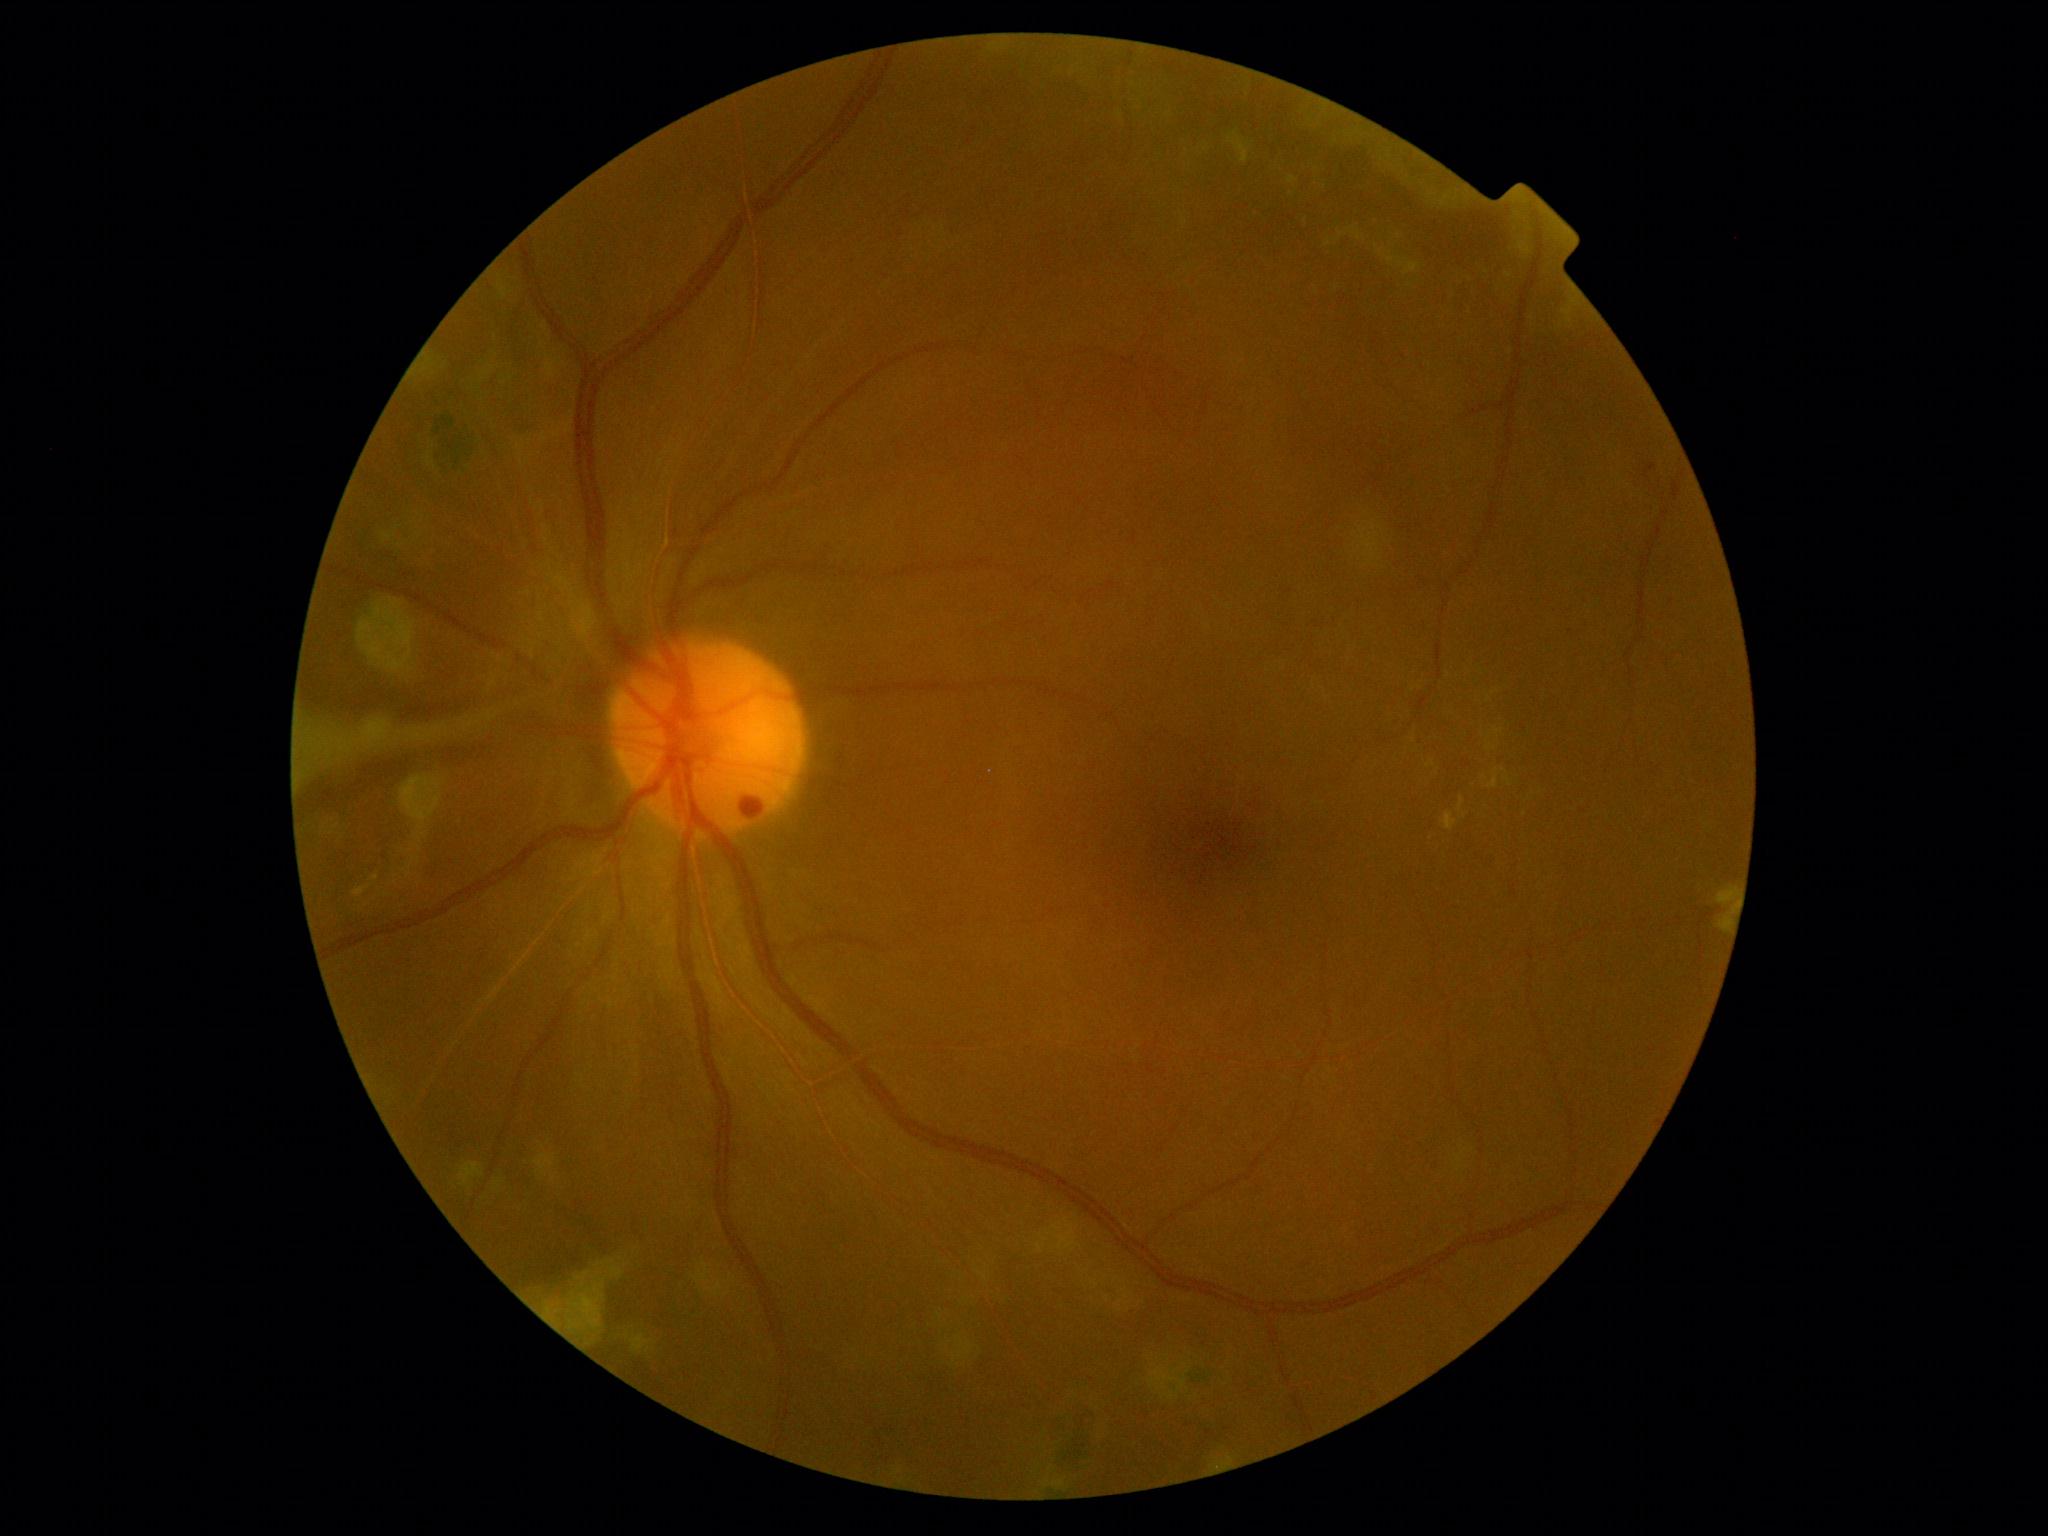
* DR grade: proliferative diabetic retinopathy (4)